848 by 848 pixels
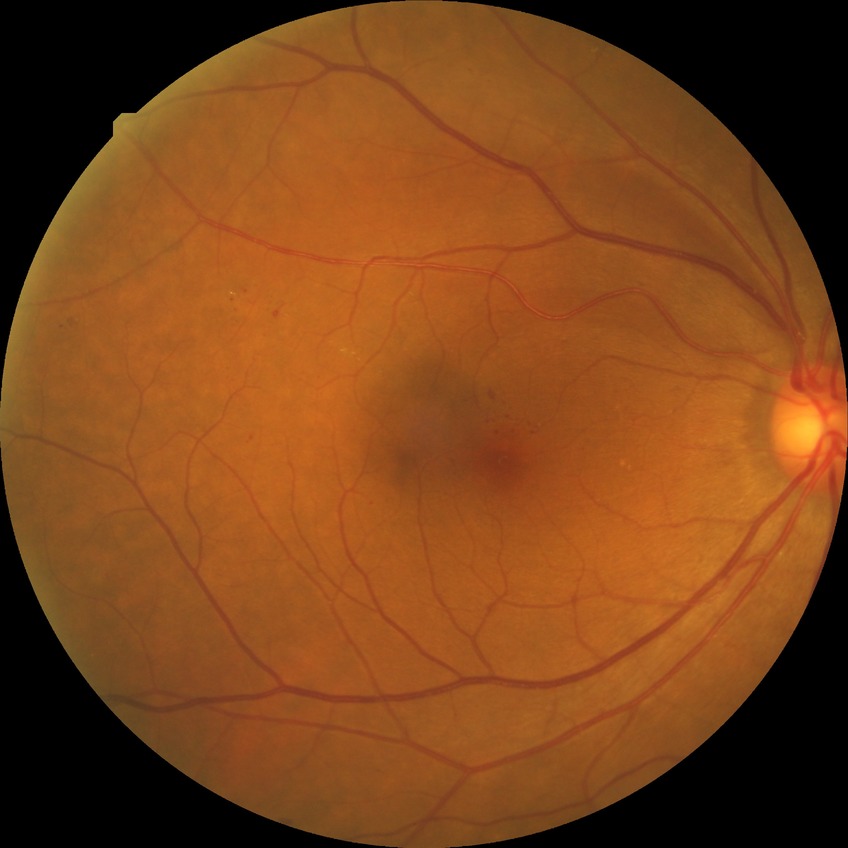
Retinopathy grade is simple diabetic retinopathy. DR class: non-proliferative diabetic retinopathy.